Pediatric retinal photograph (wide-field) — 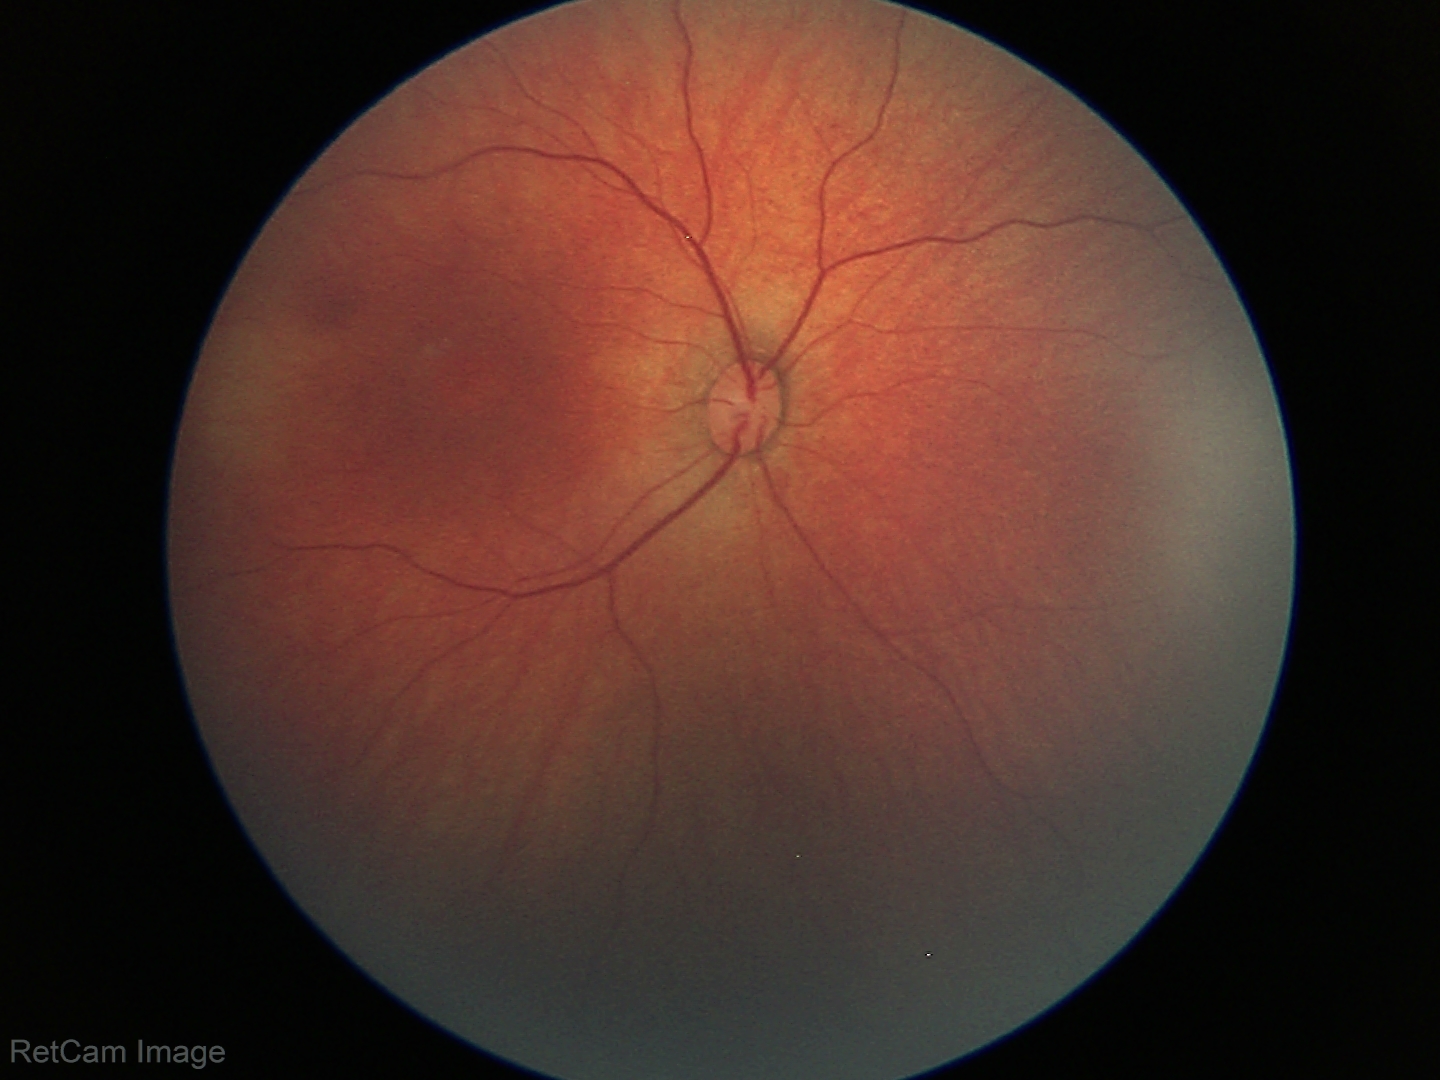

No retinal pathology identified on screening.